1920x1440px. Retinal fundus photograph:
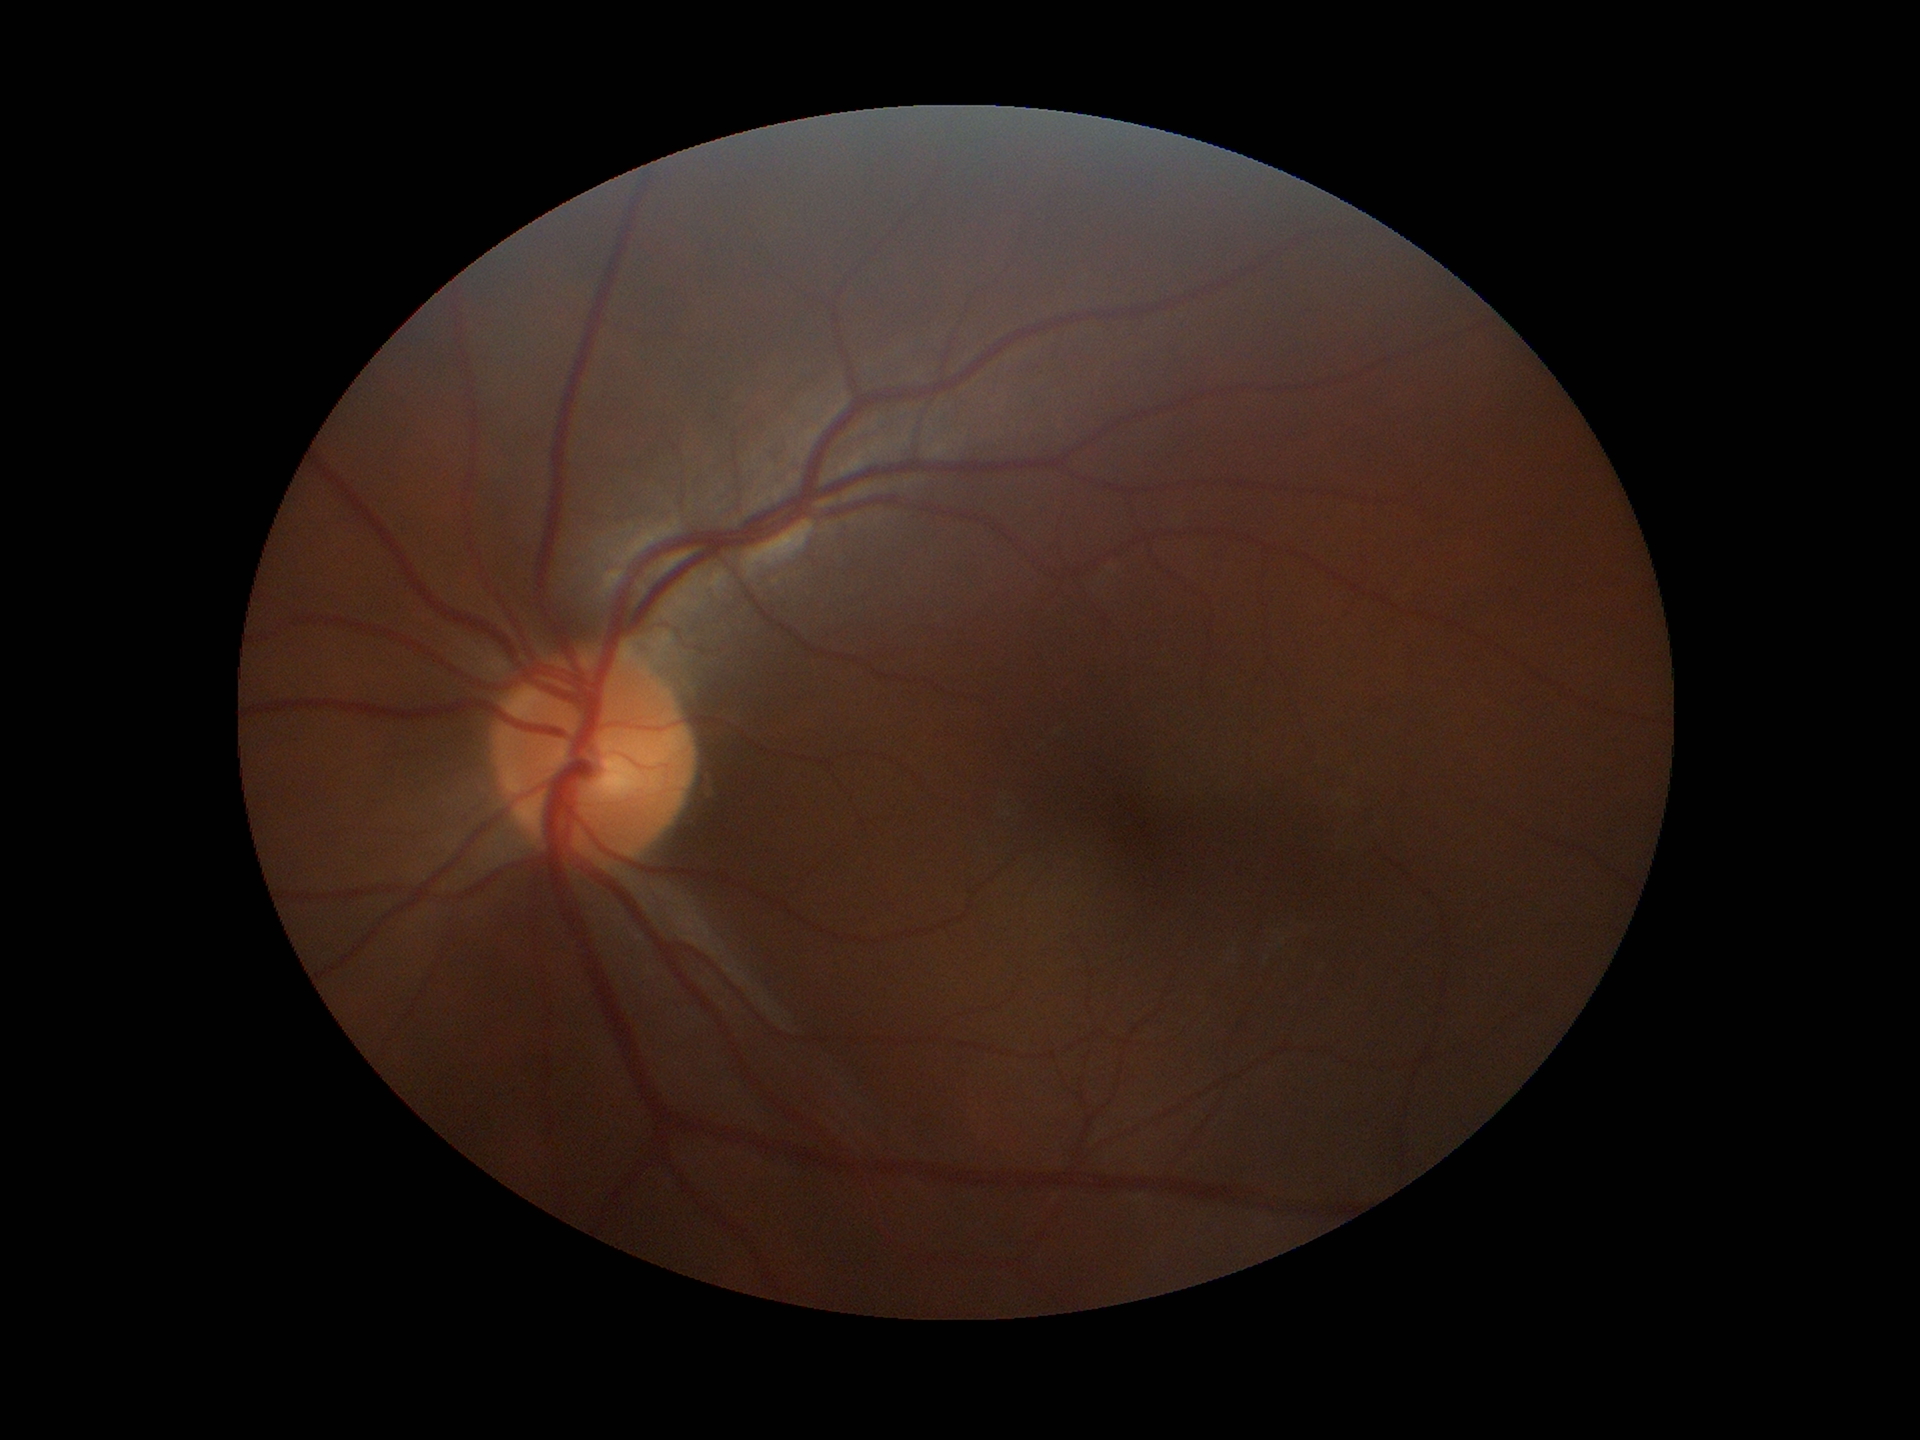

vertical cup-disc ratio: 0.44
Glaucoma screening: no suspicious findings